Wide-field fundus image from infant ROP screening. 130° field of view (Clarity RetCam 3): 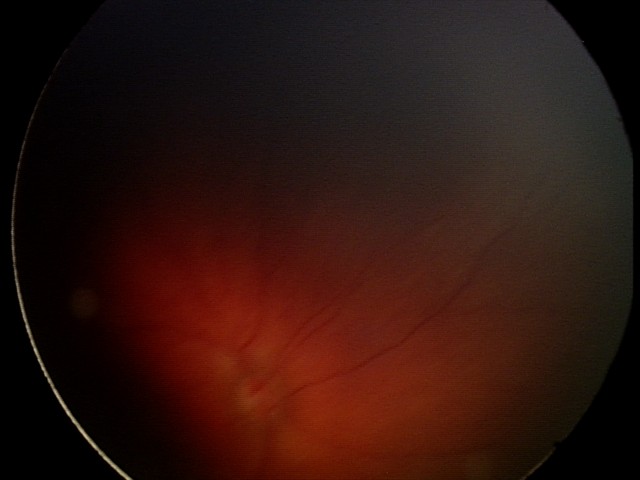 From an examination with diagnosis of retinal hemorrhages.